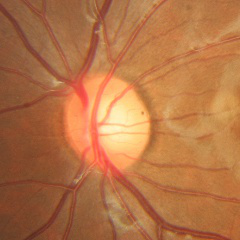 Optic disc appearance consistent with no glaucoma.